Camera: NIDEK AFC-230, nonmydriatic fundus photograph, 45° field of view.
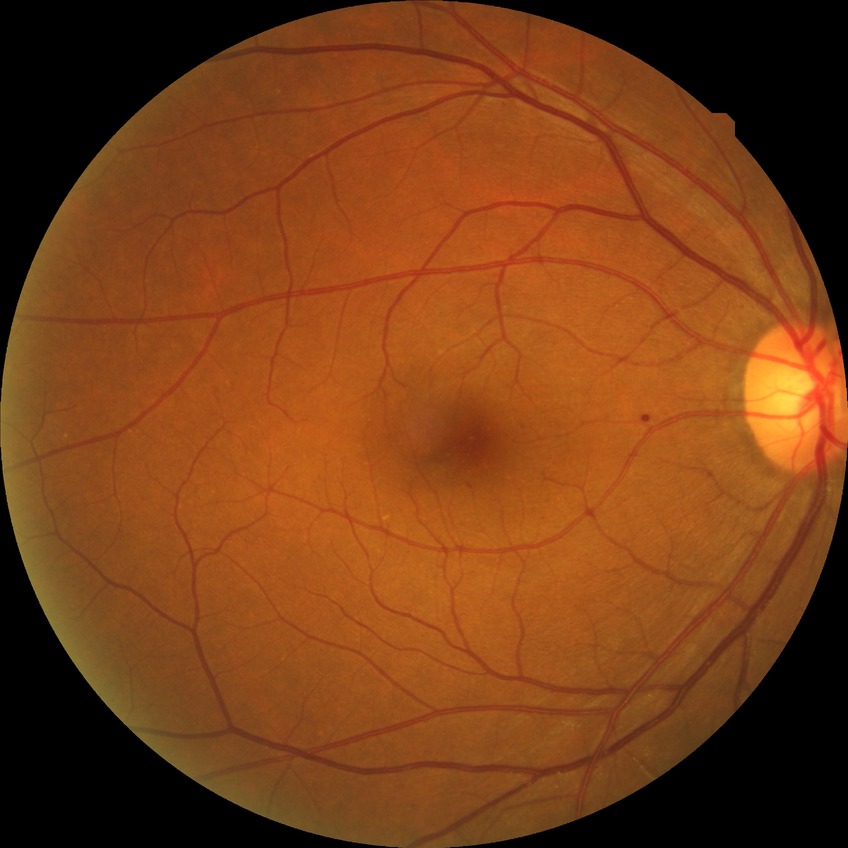 Davis grading is simple diabetic retinopathy.